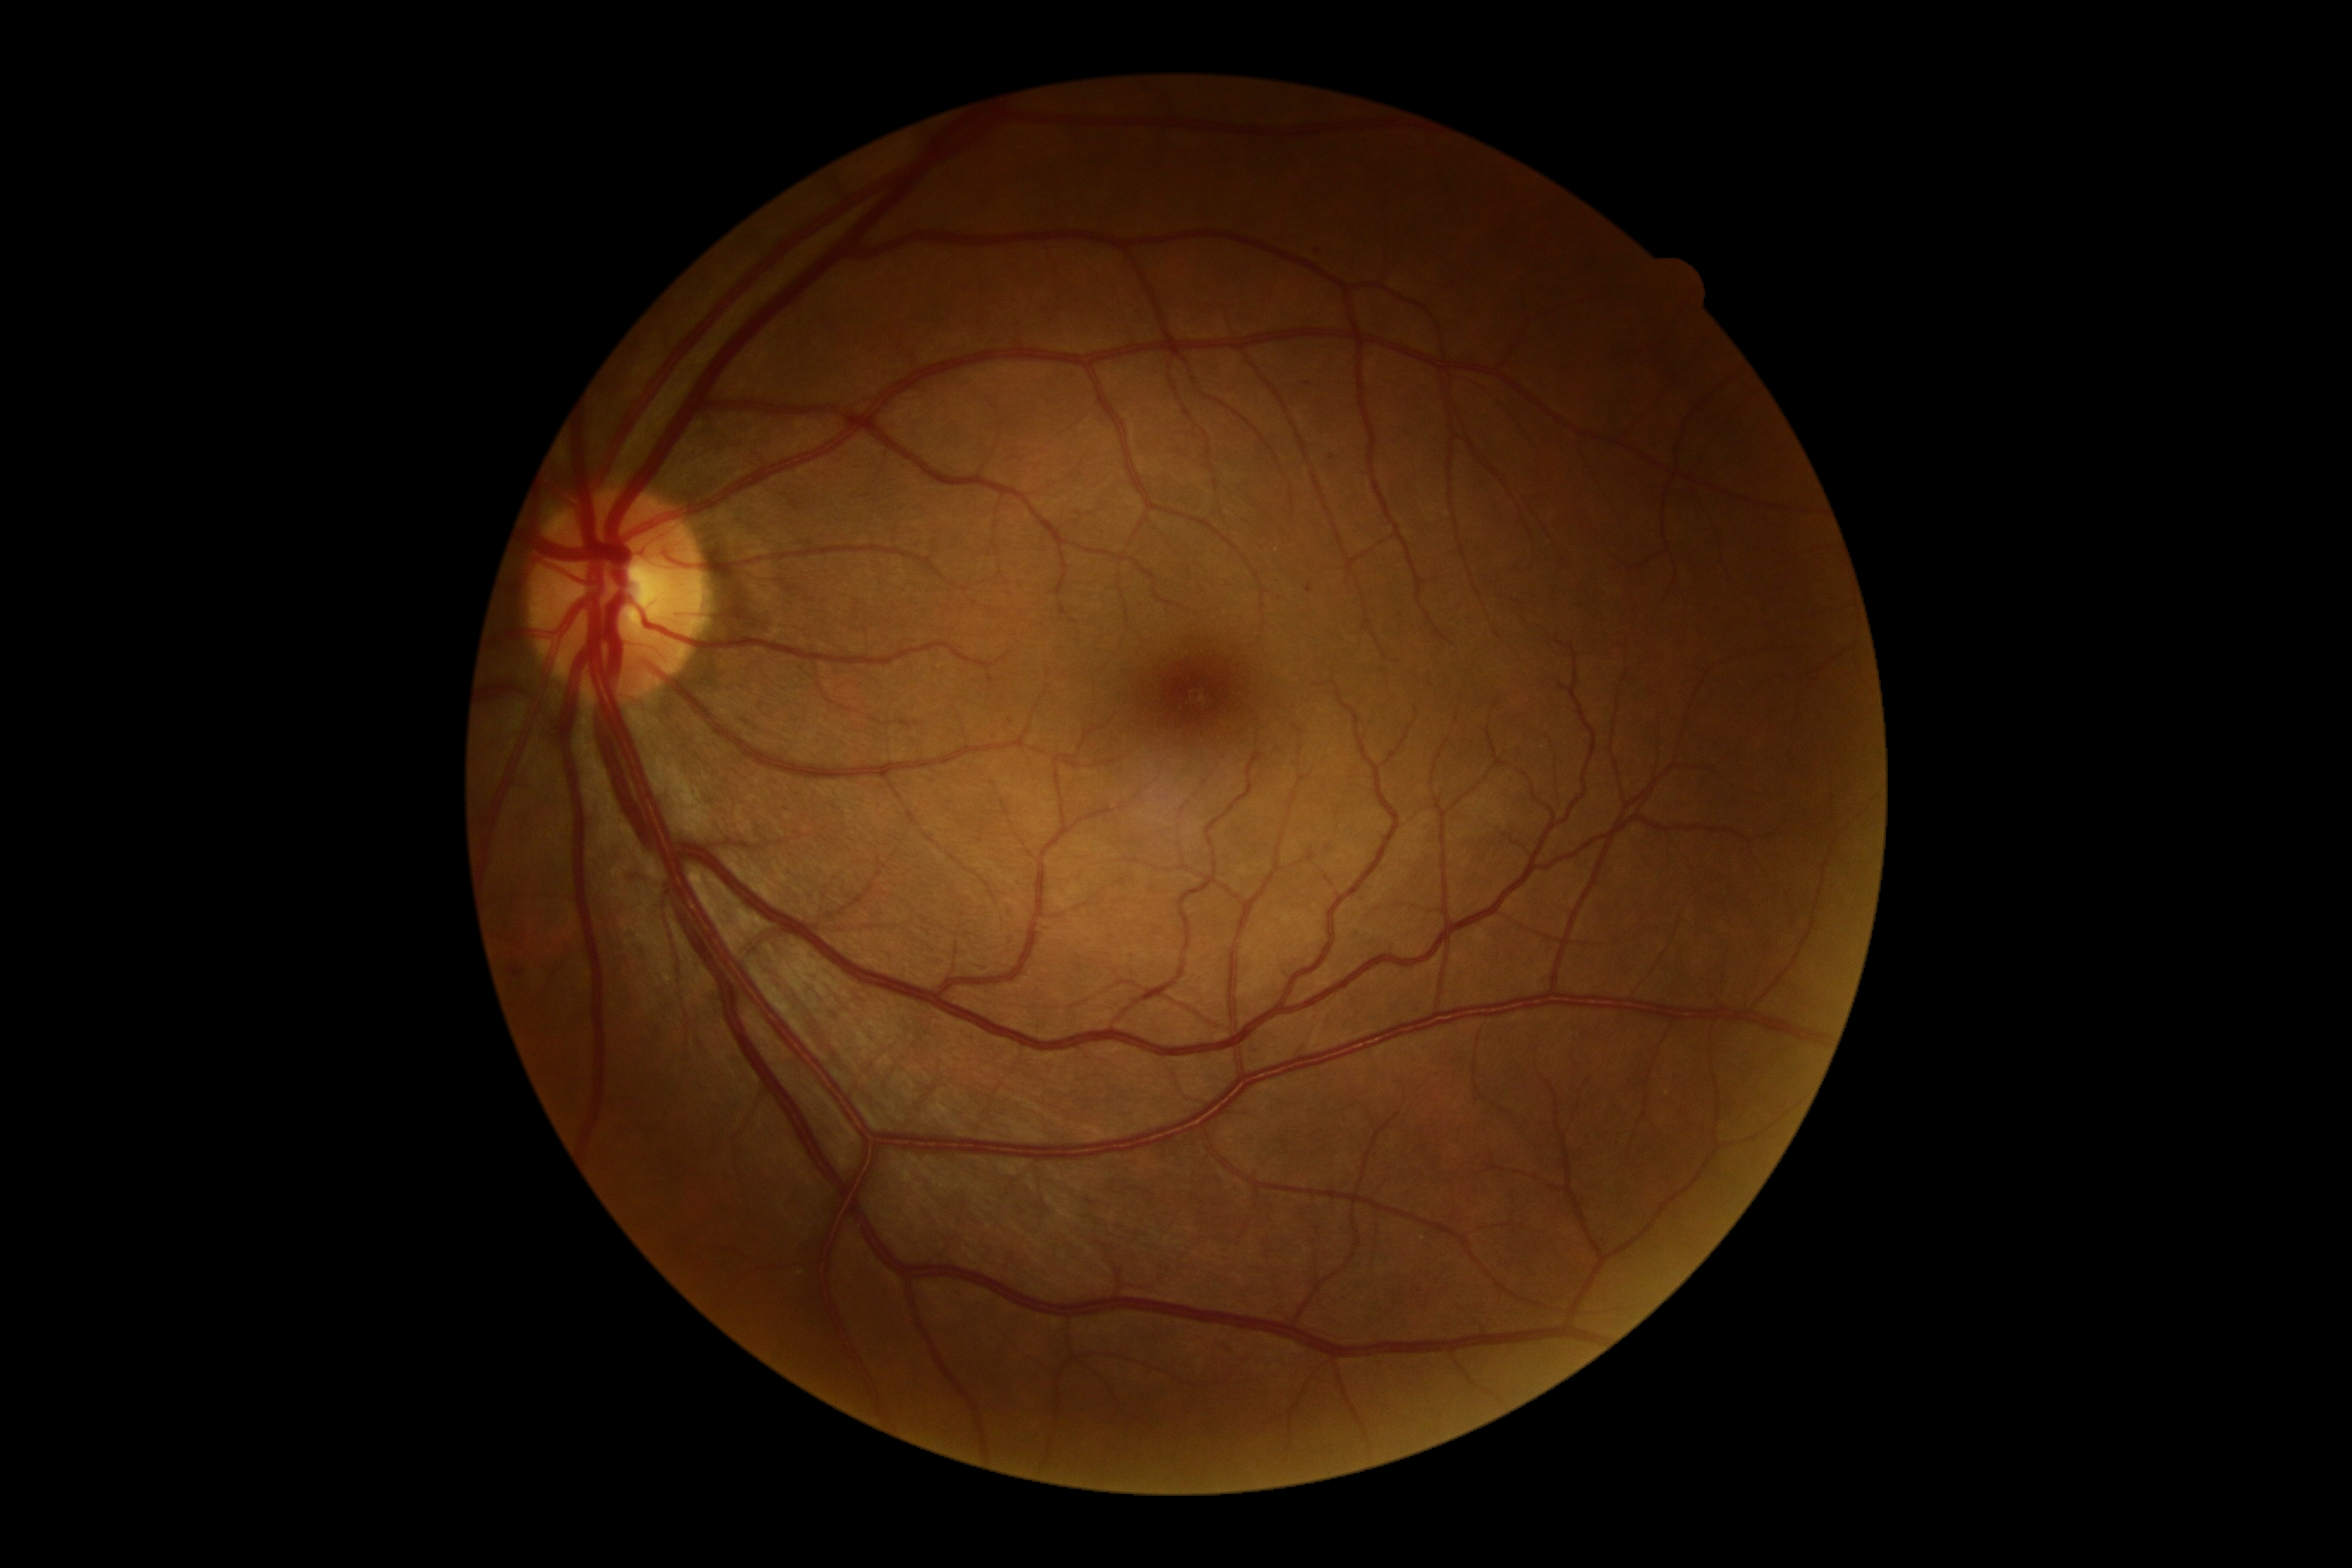 DR grade: 1/4.